Color fundus image.
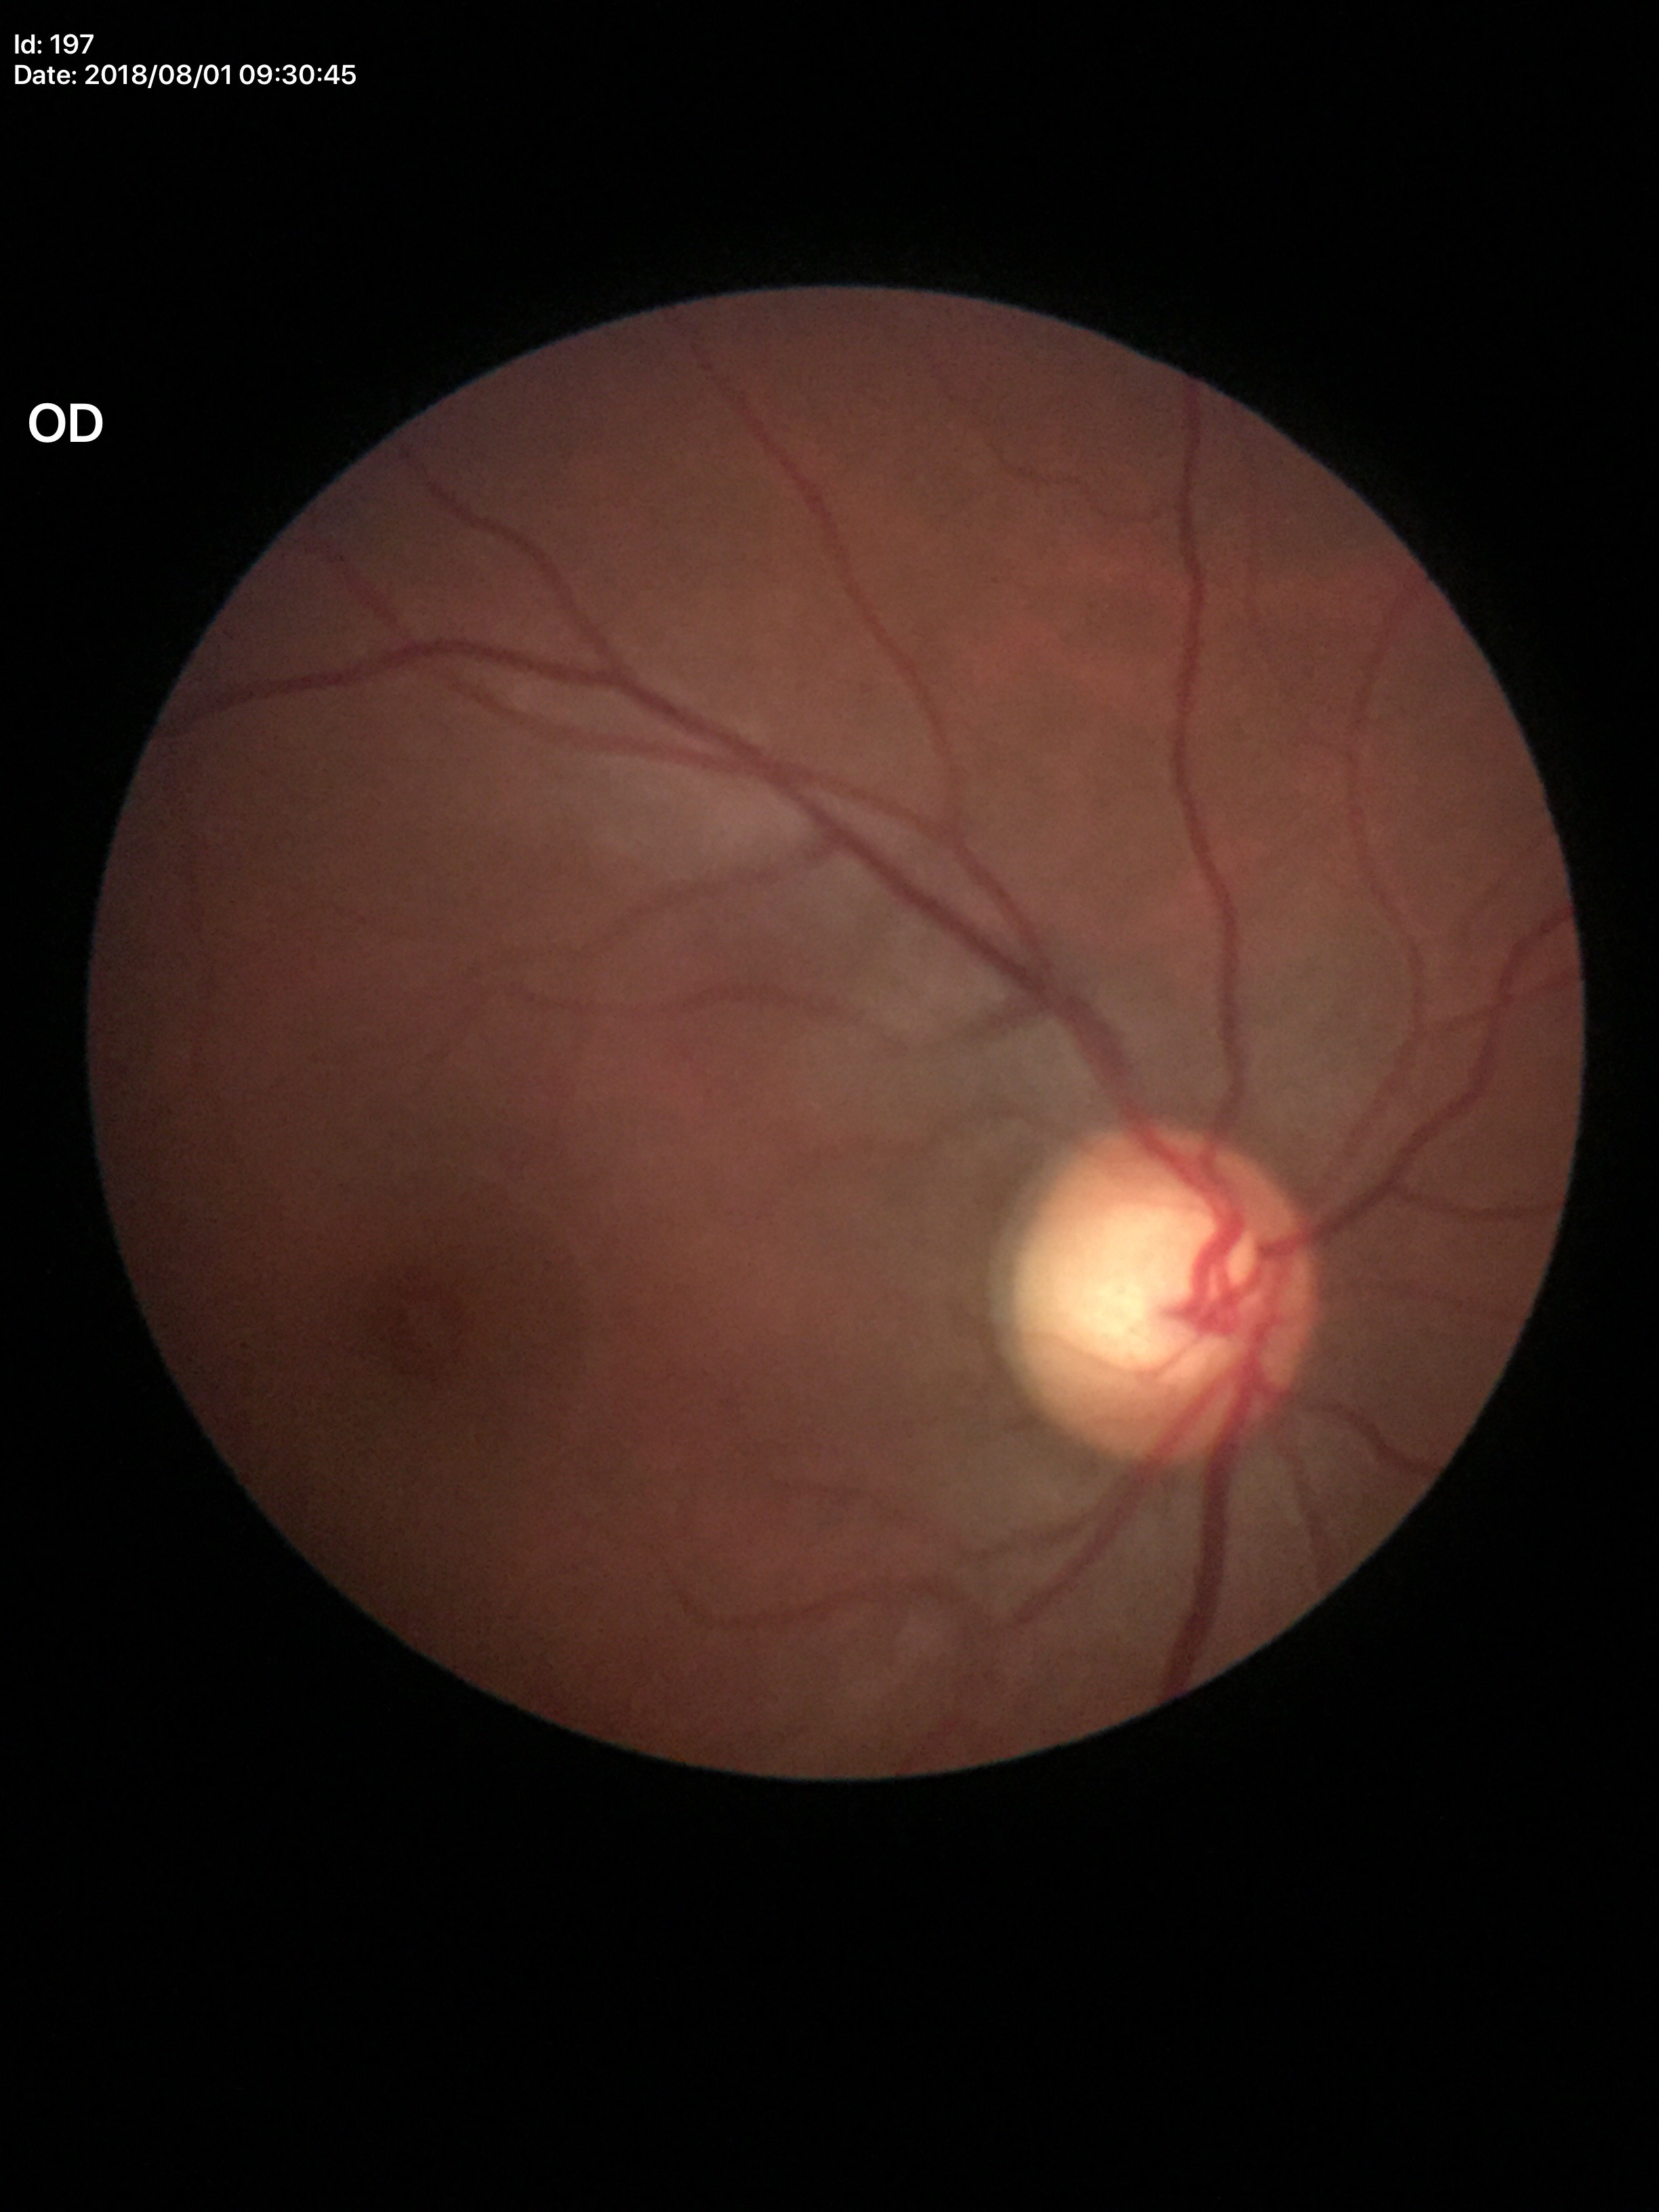 Optic disc analysis:
– VCDR: 0.67
– Glaucoma decision: suspicious